640x480. Wide-field fundus photograph from neonatal ROP screening.
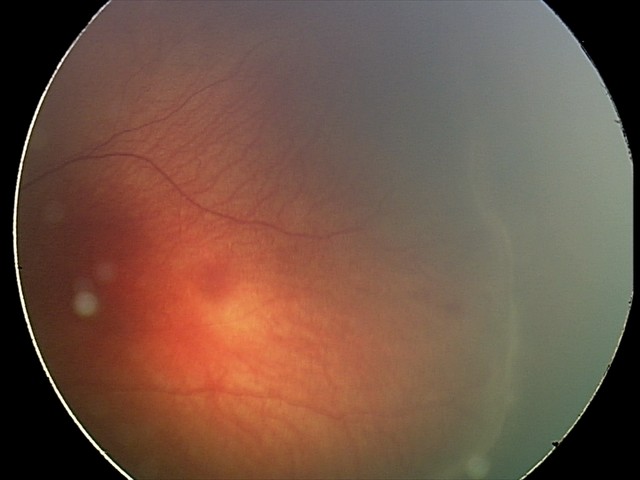
Diagnosis from this screening exam: retinopathy of prematurity stage 2.
Plus disease absent.